Image size 2352x1568, 45-degree field of view, color fundus image.
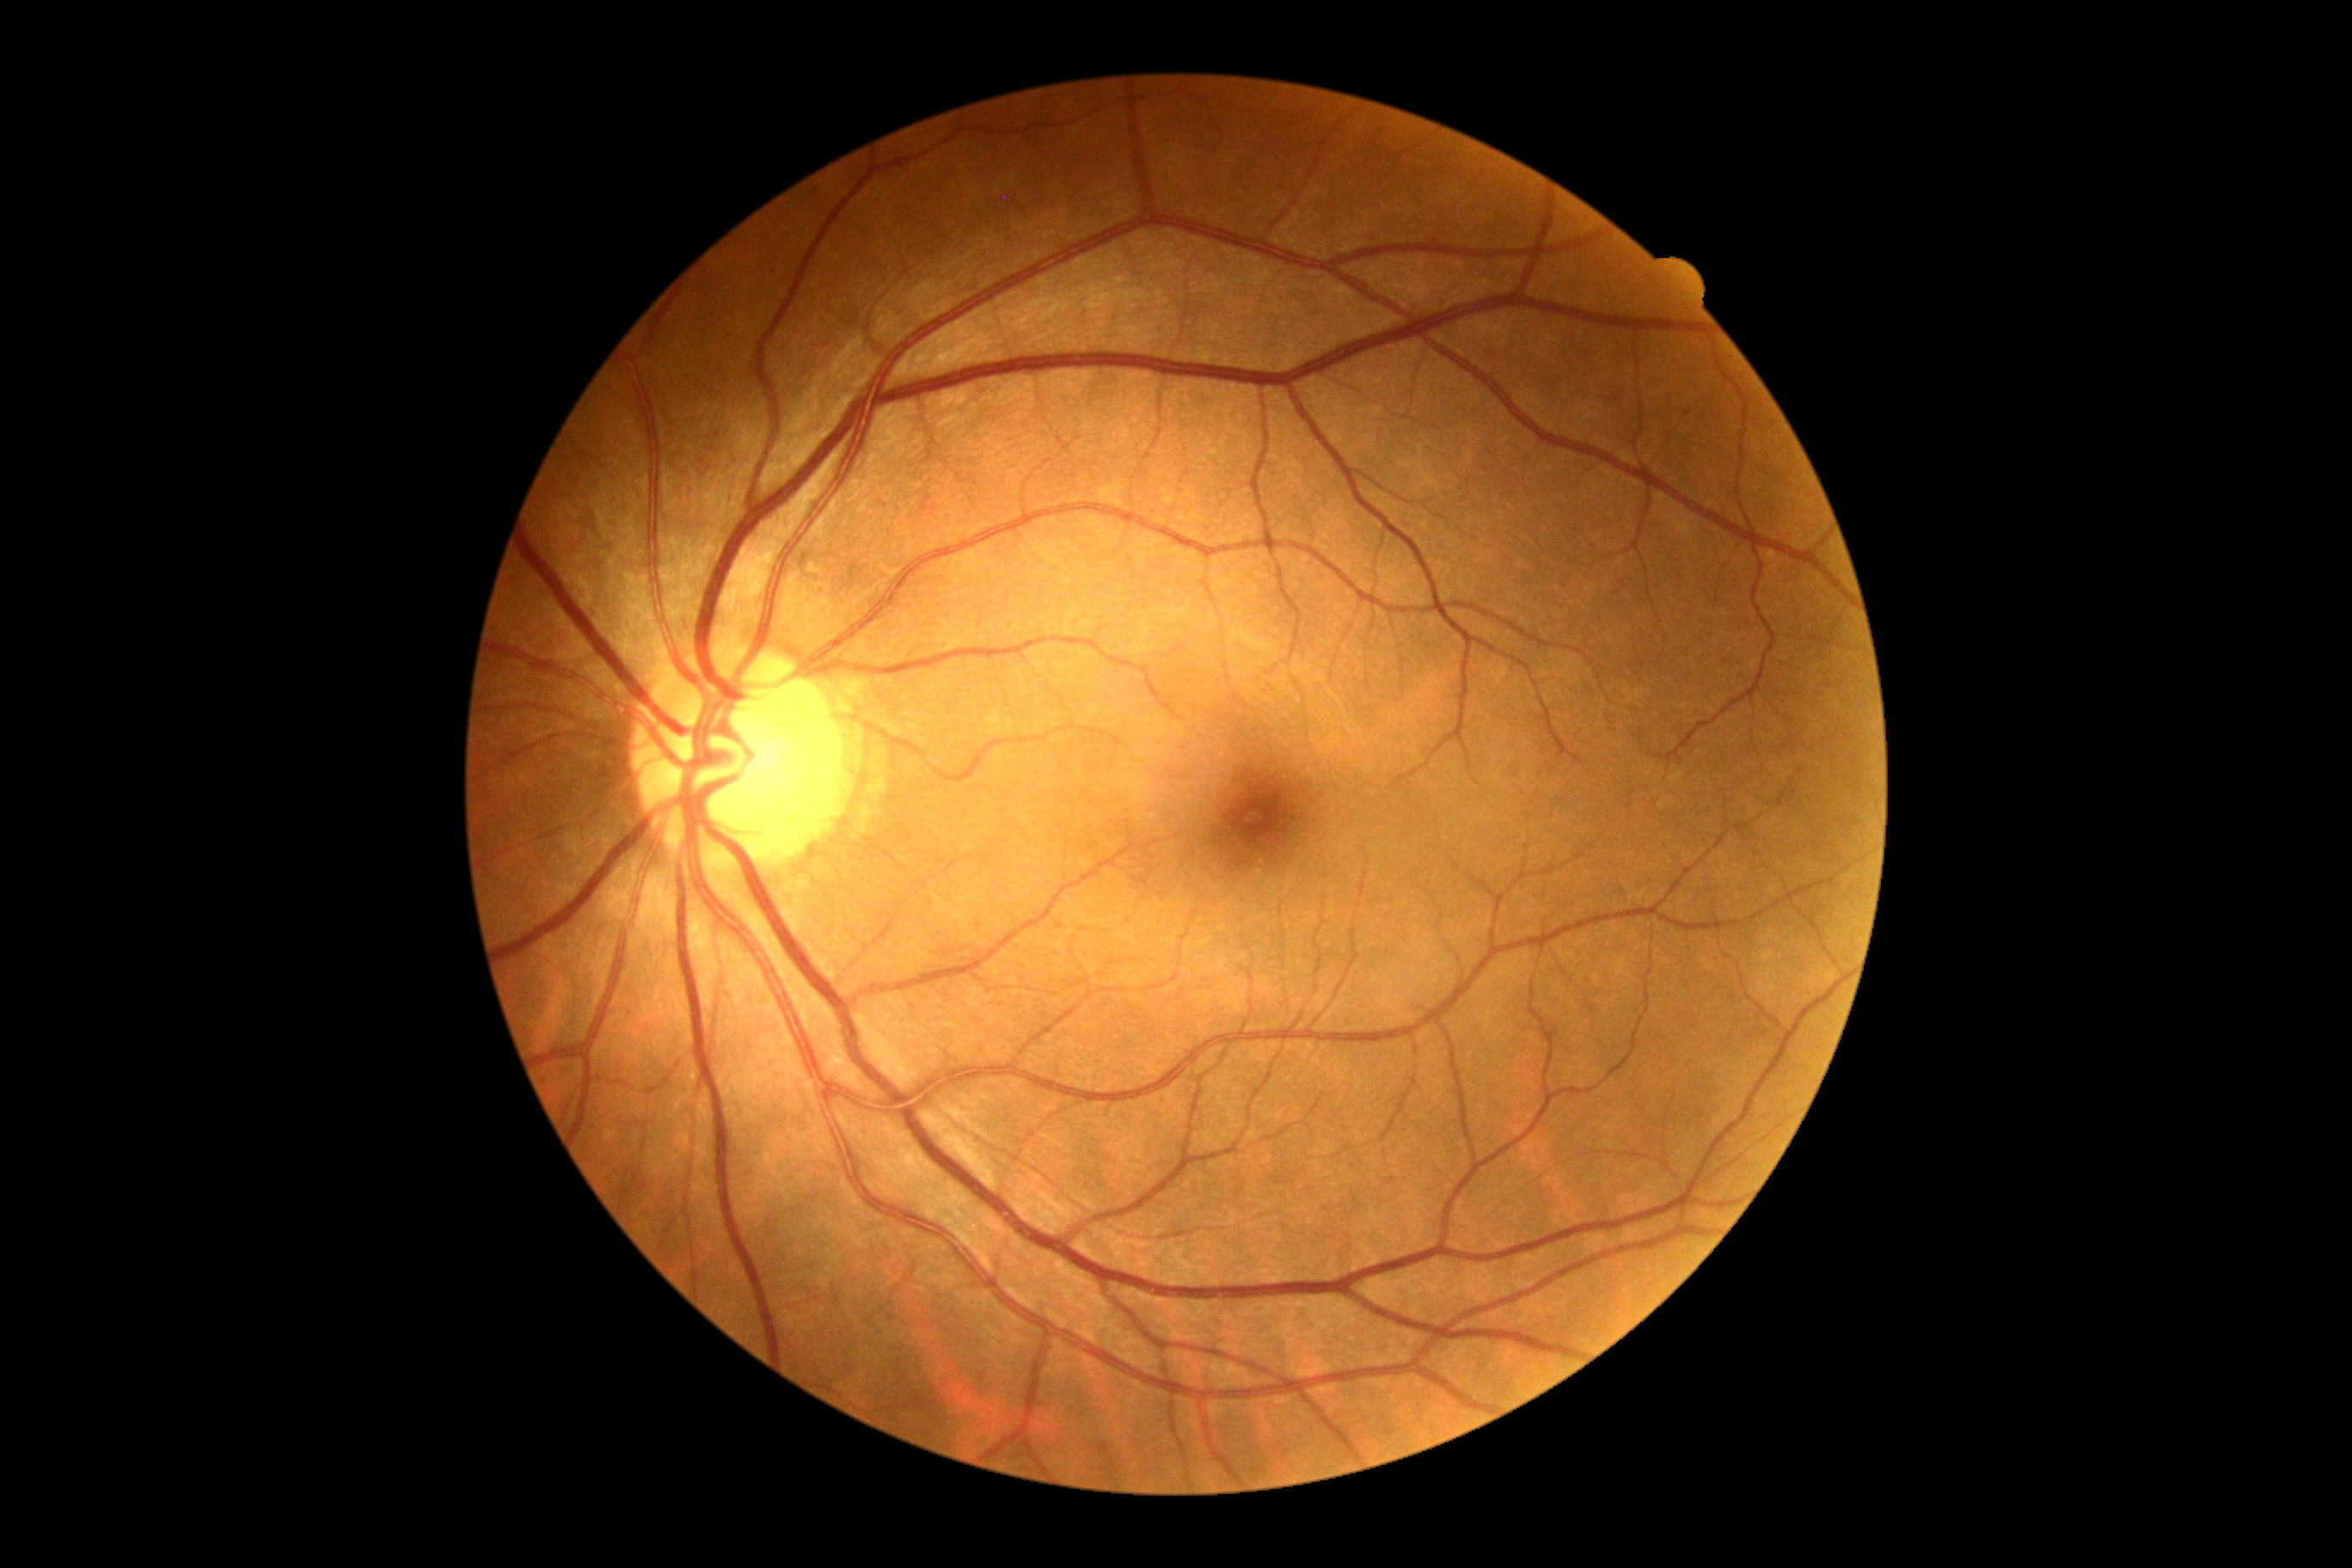

No apparent diabetic retinopathy. DR stage is grade 0 (no apparent retinopathy).